848 by 848 pixels
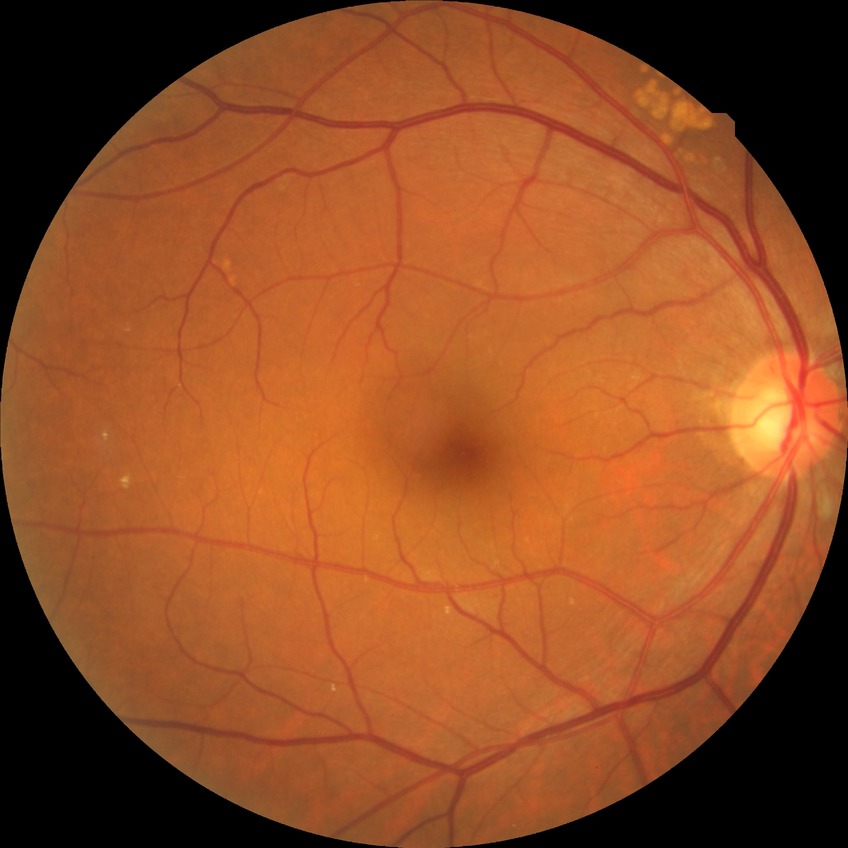

diabetic retinopathy (DR) = no diabetic retinopathy (NDR).